Graded on the modified Davis scale.
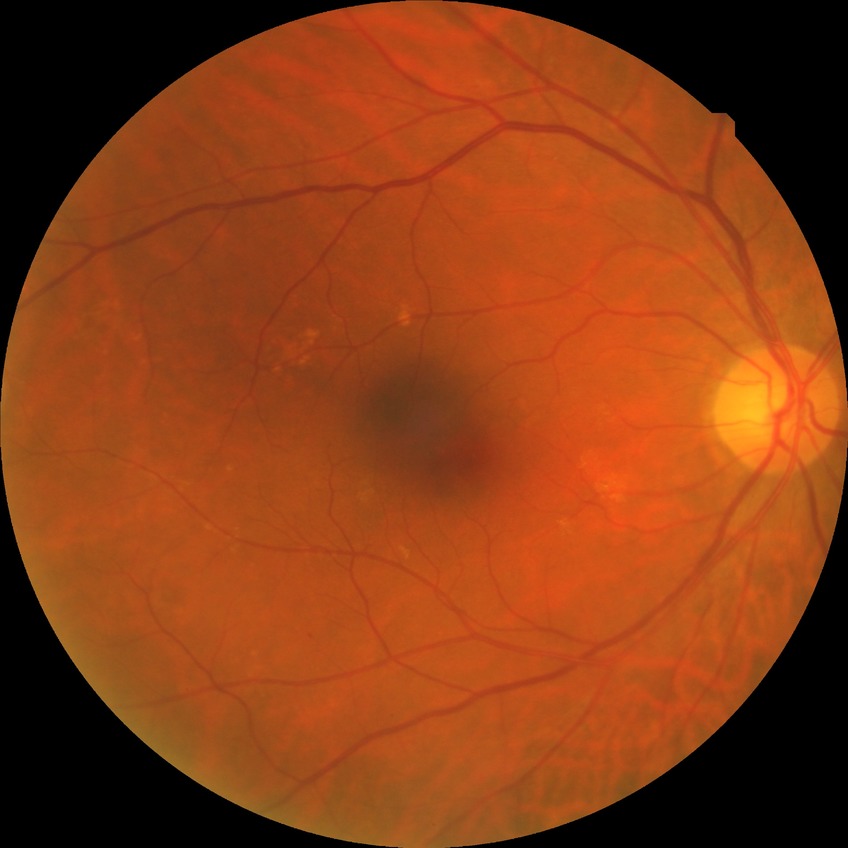

DR: SDR. DR class: non-proliferative diabetic retinopathy.